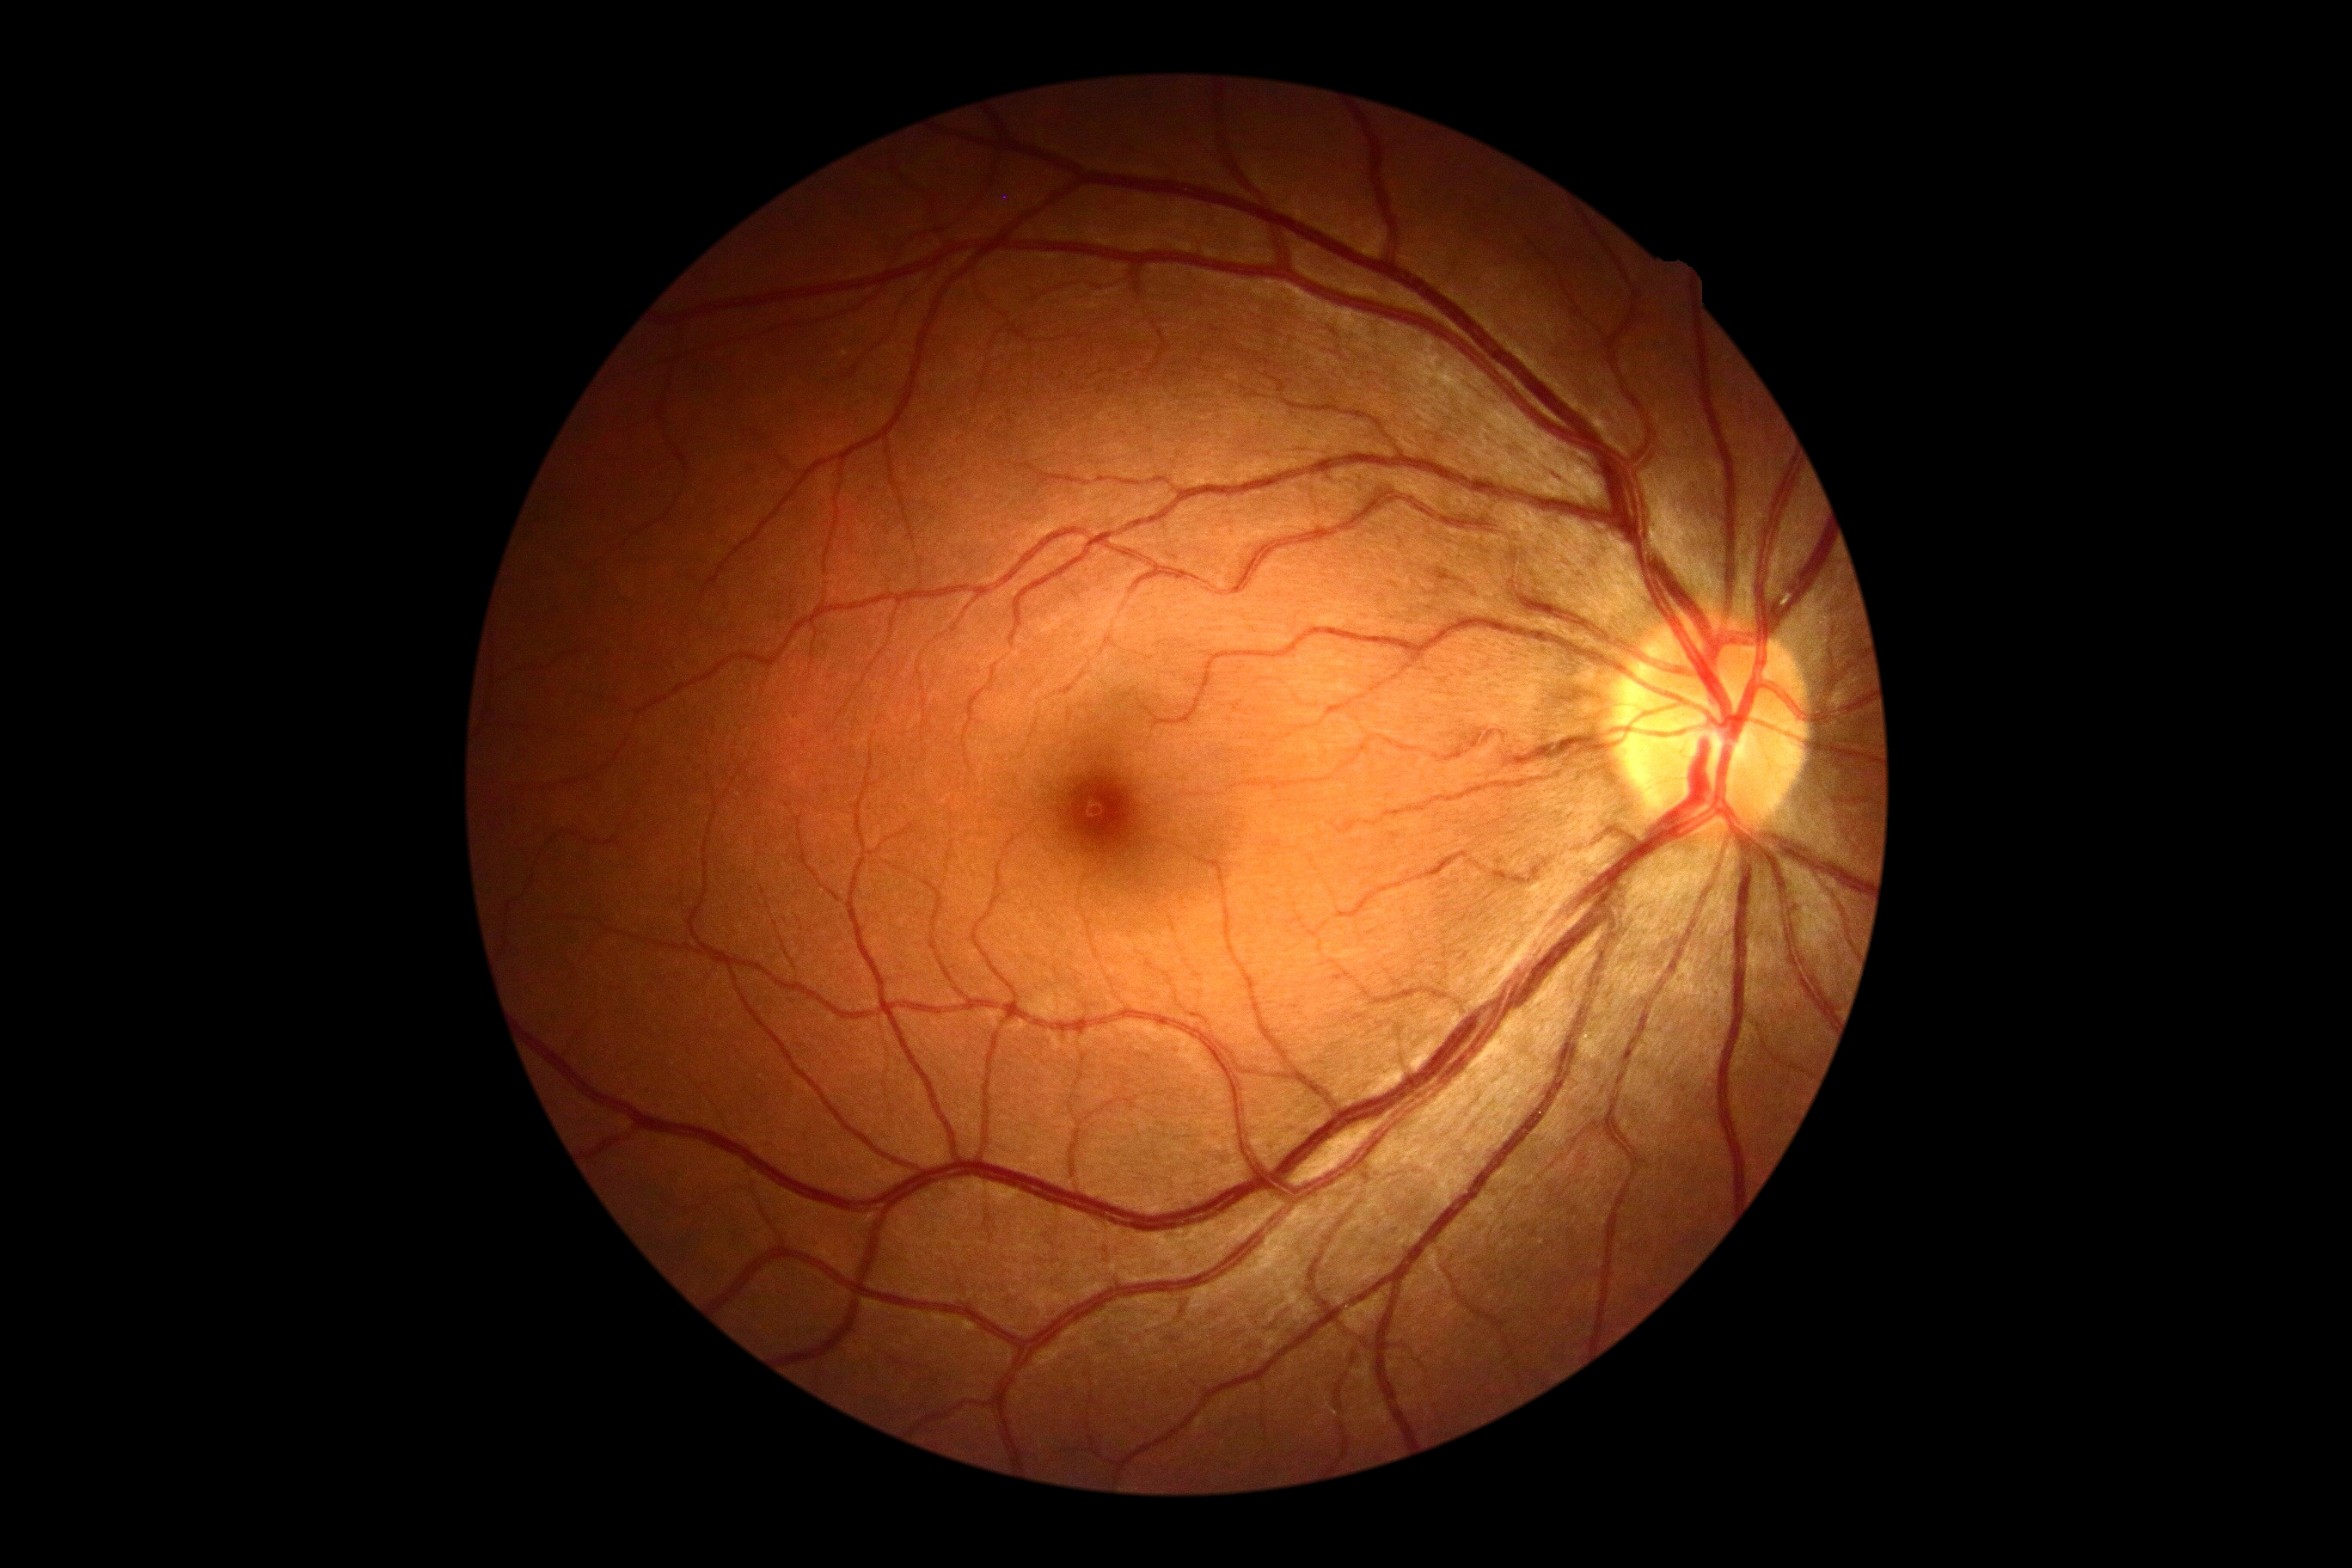

DR=grade 0 (no apparent retinopathy) — no visible signs of diabetic retinopathy, DR impression=no signs of DR.